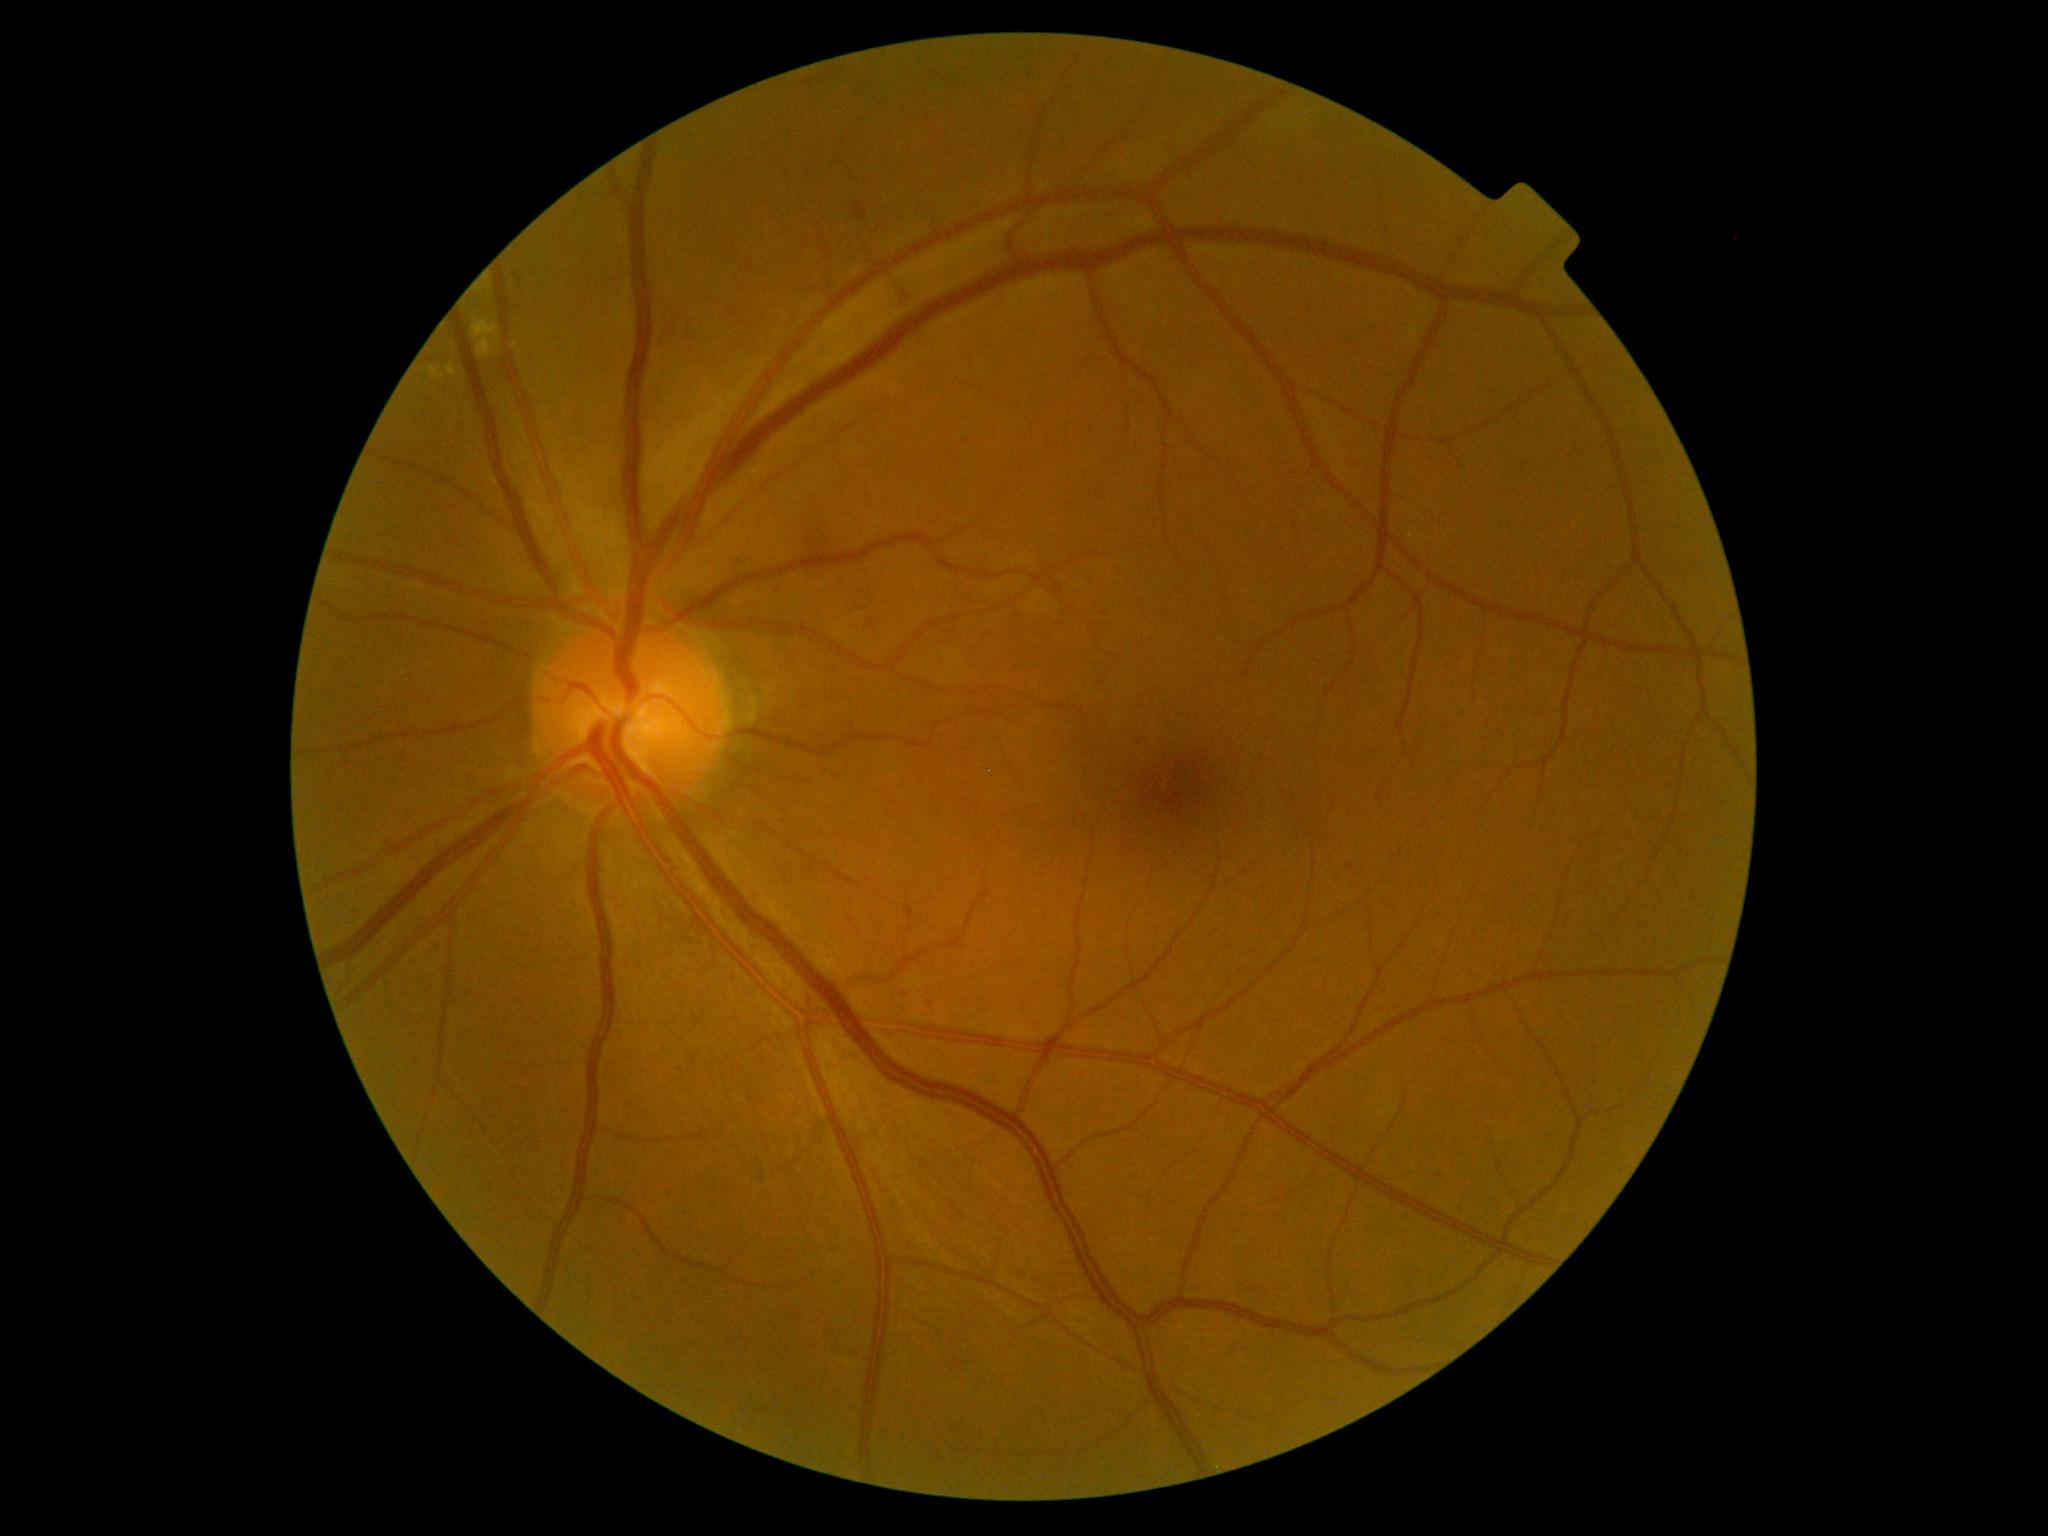 DR grade: 2.